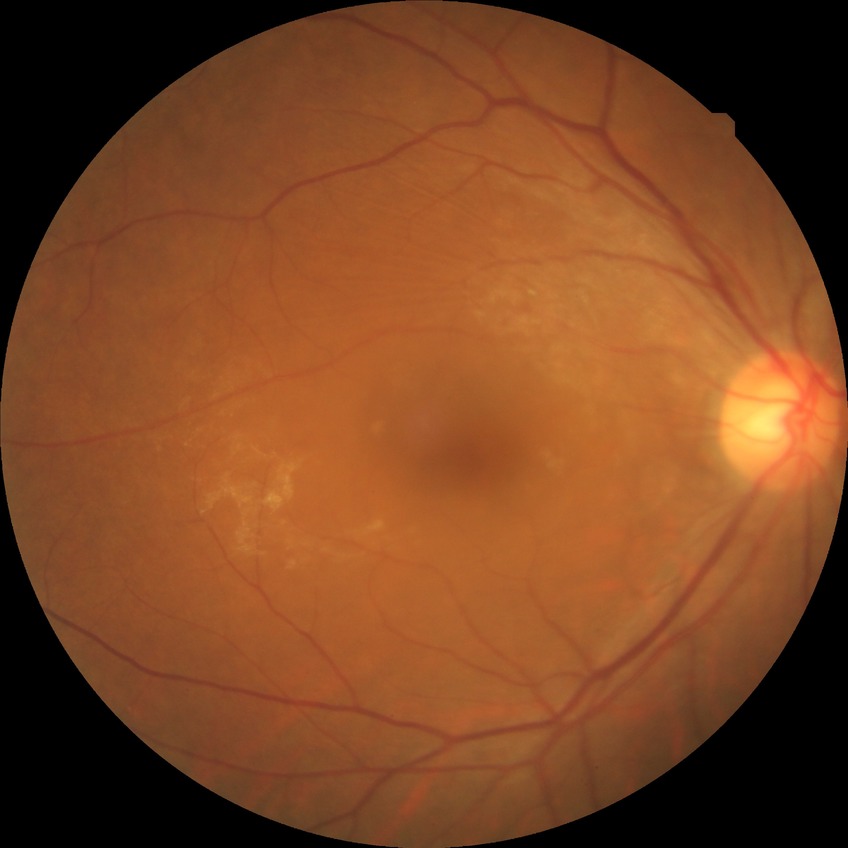

Diabetic retinopathy (DR): NDR (no diabetic retinopathy).